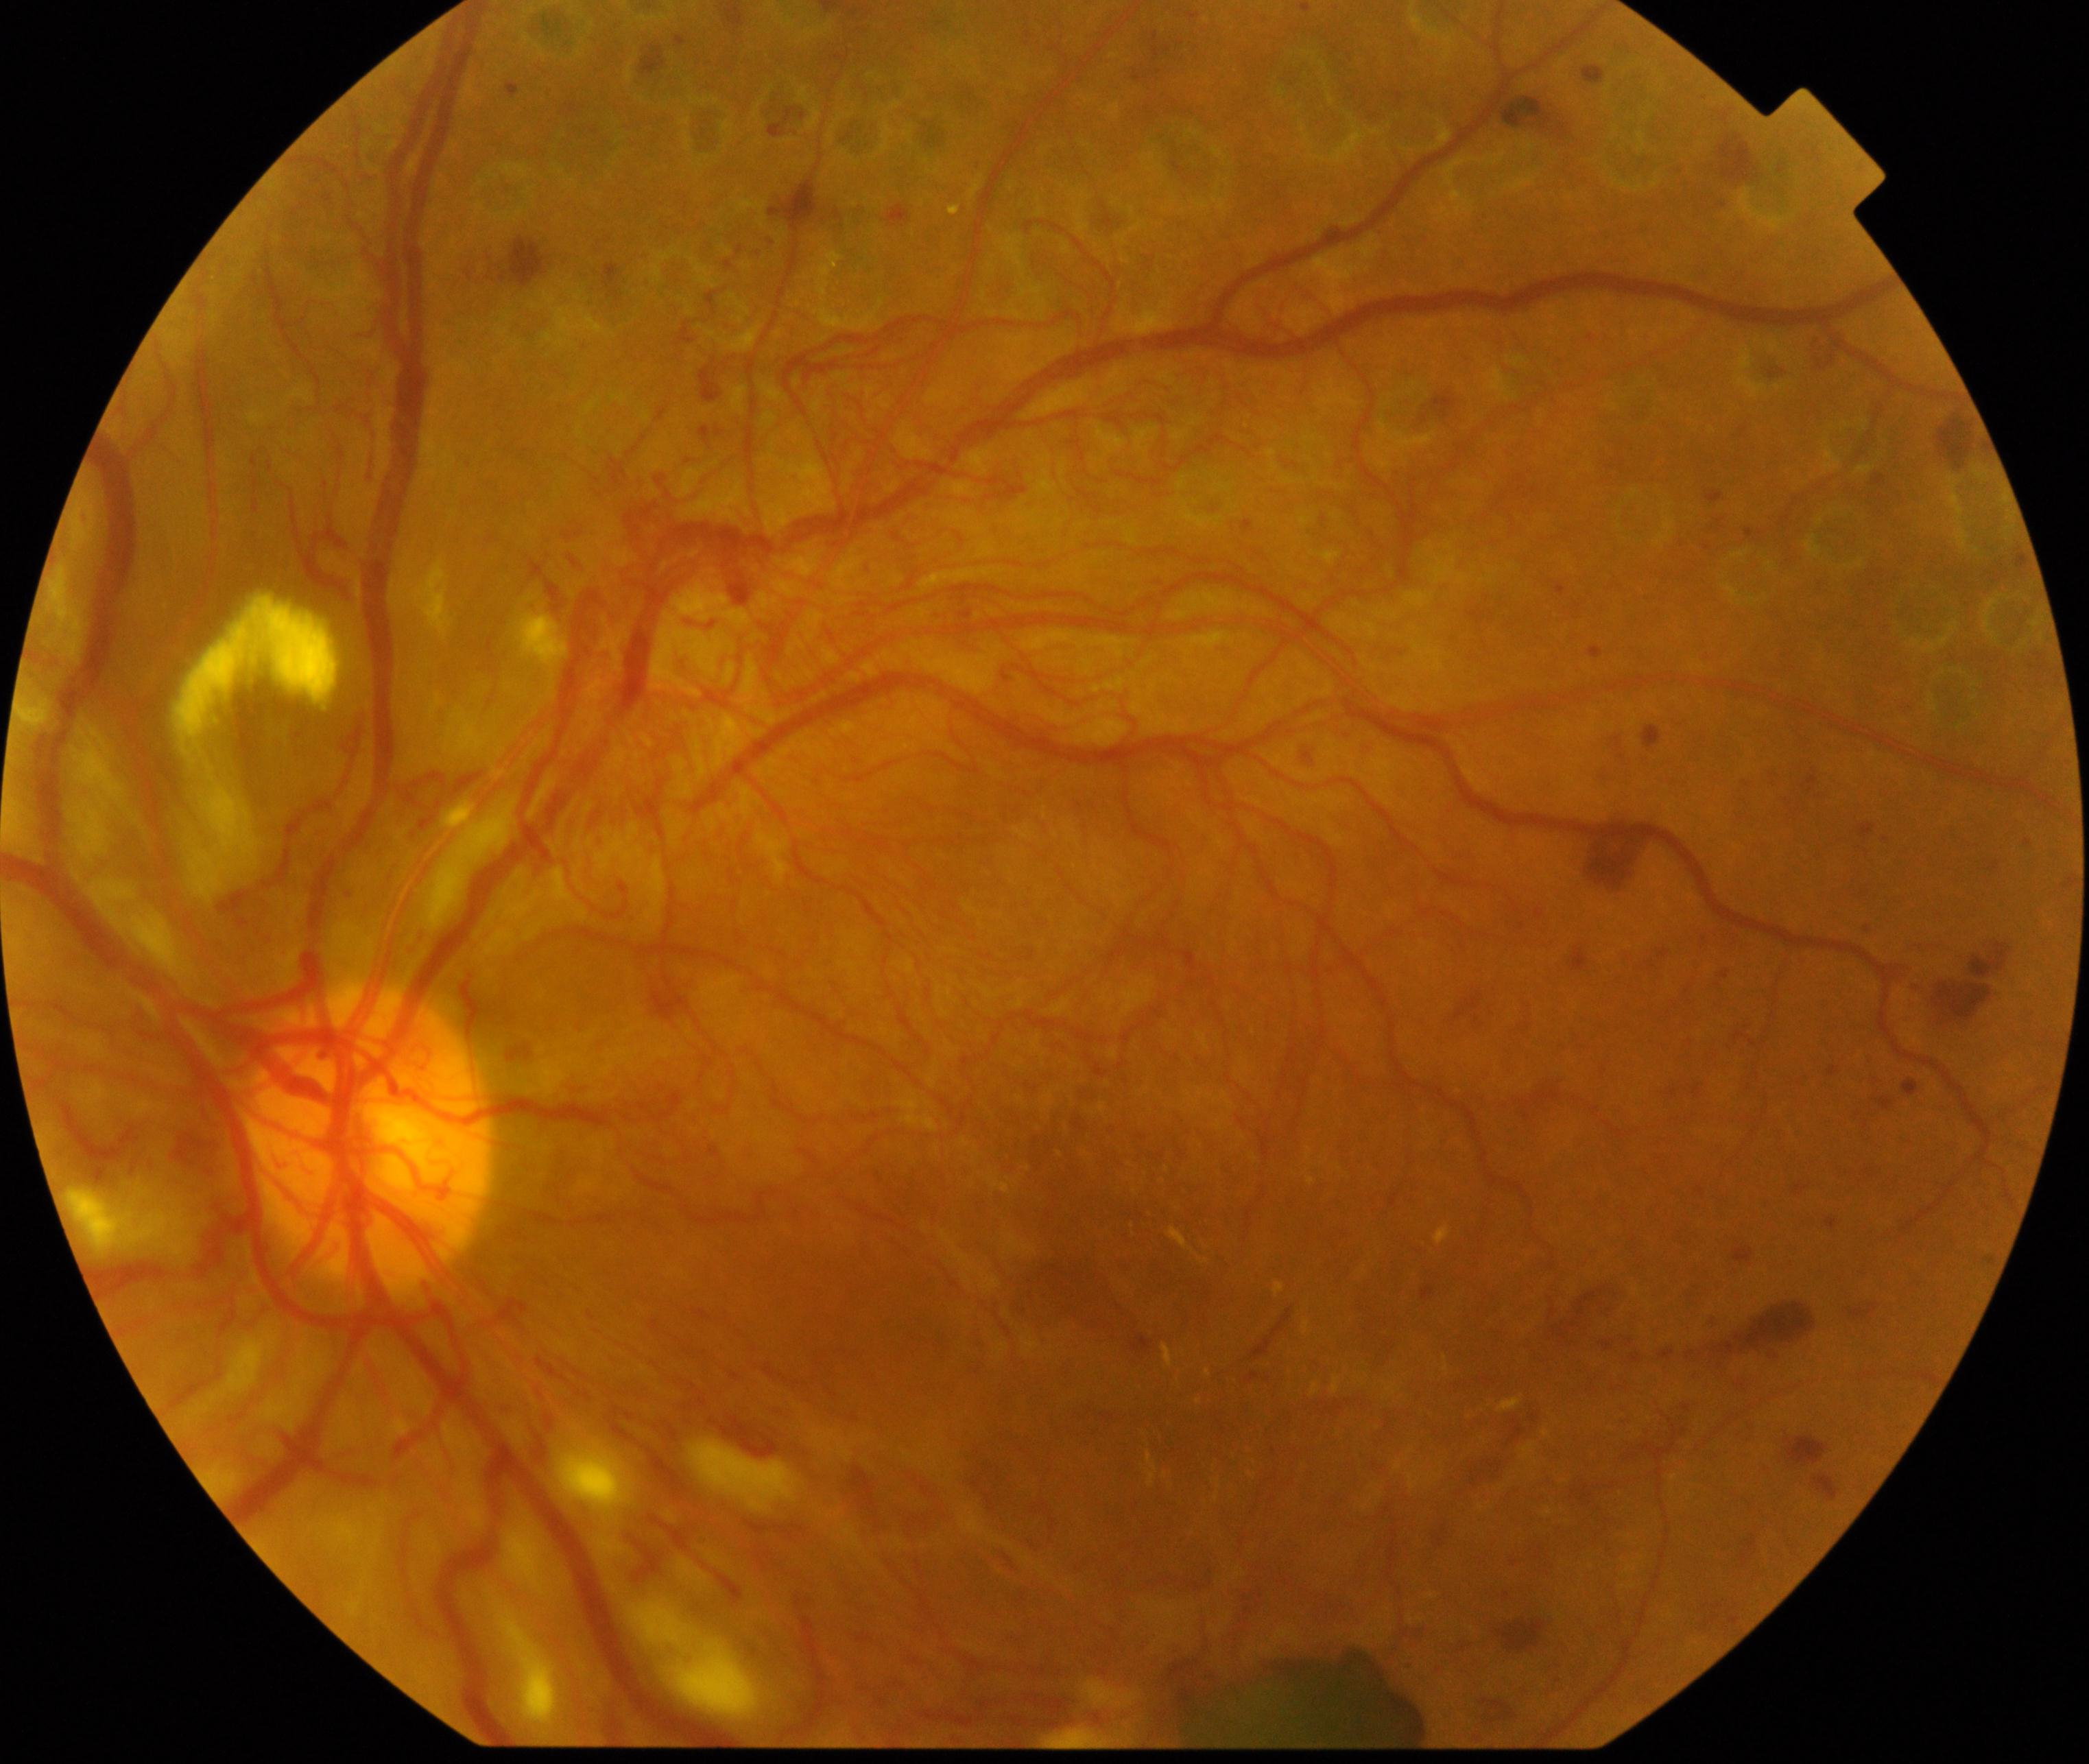 Retinal fundus photograph demonstrating severe non-proliferative or proliferative diabetic retinopathy.